1960 by 1897 pixels, 45° FOV, CFP: 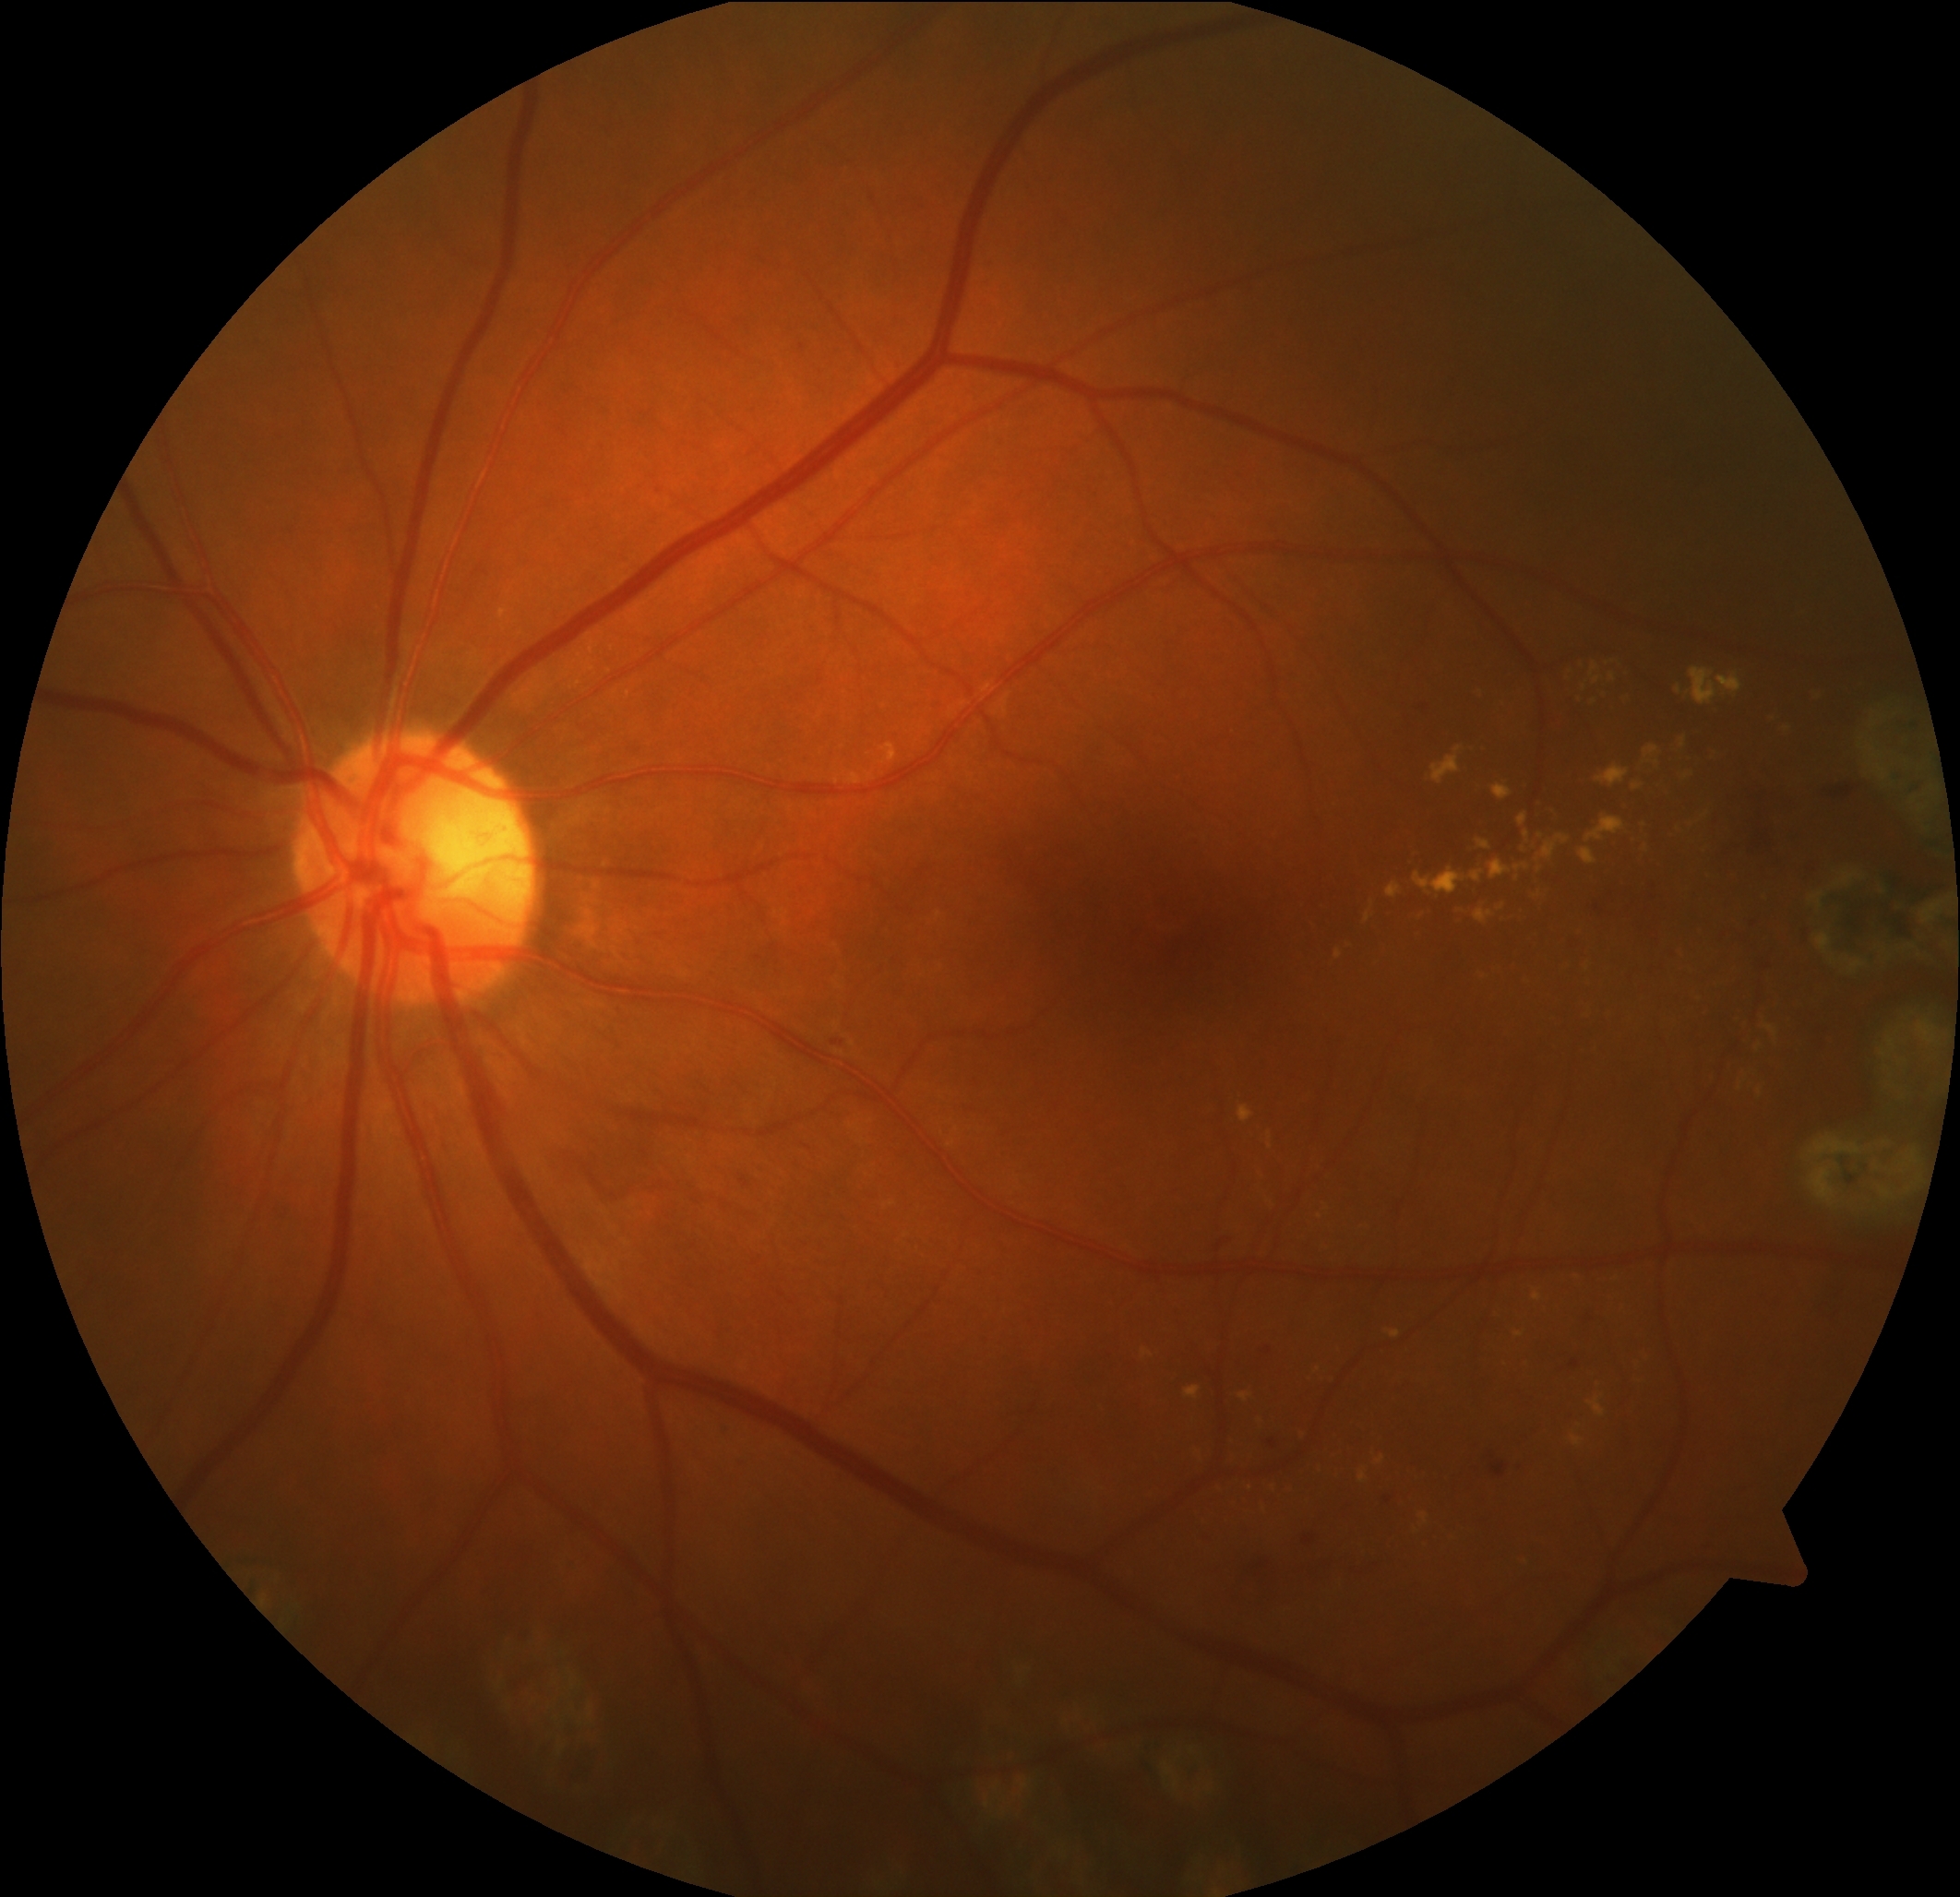
DR stage: moderate NPDR (grade 2).